640x480px · infant wide-field retinal image.
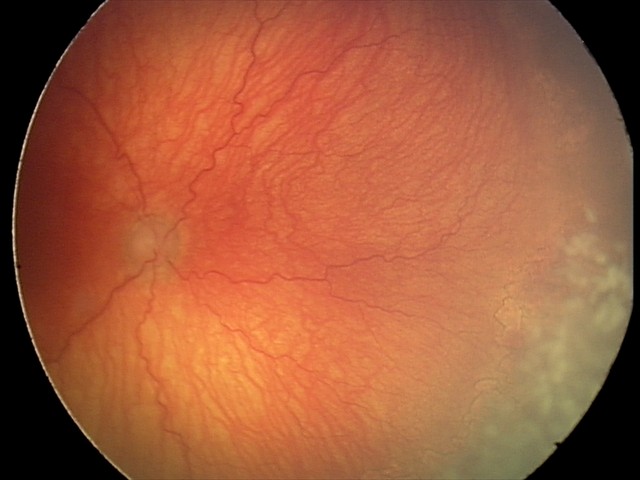 Assessment: aggressive retinopathy of prematurity.